Pediatric wide-field fundus photograph
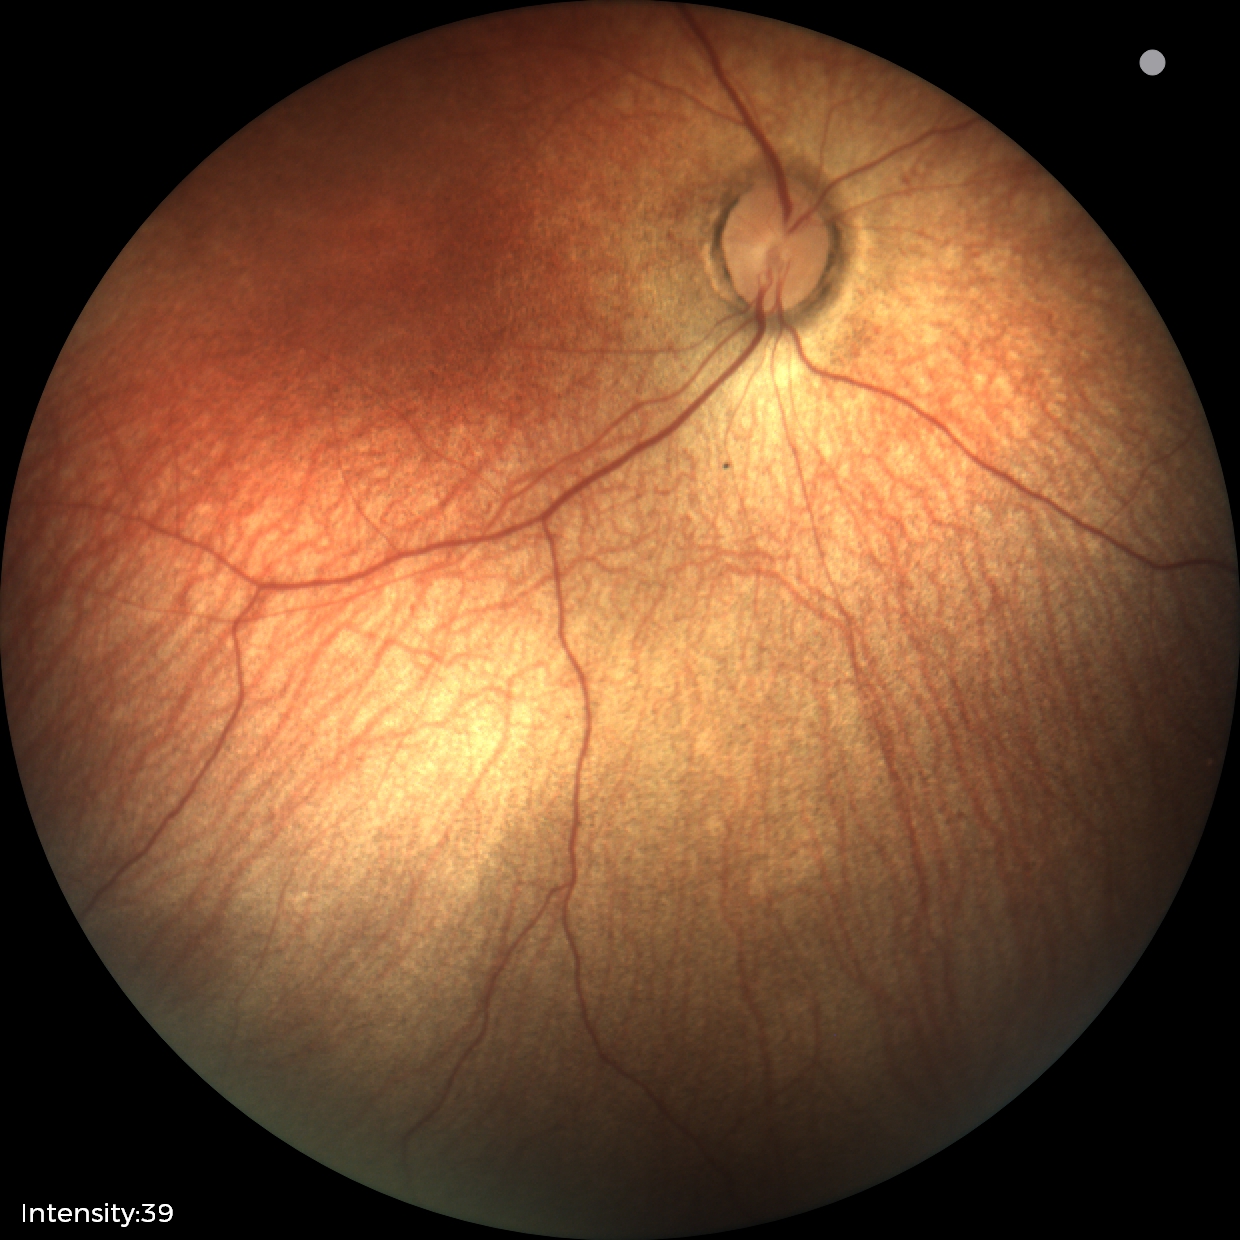 Assessment: normal retinal appearance